Pediatric retinal photograph (wide-field); captured with the Clarity RetCam 3 (130° field of view): 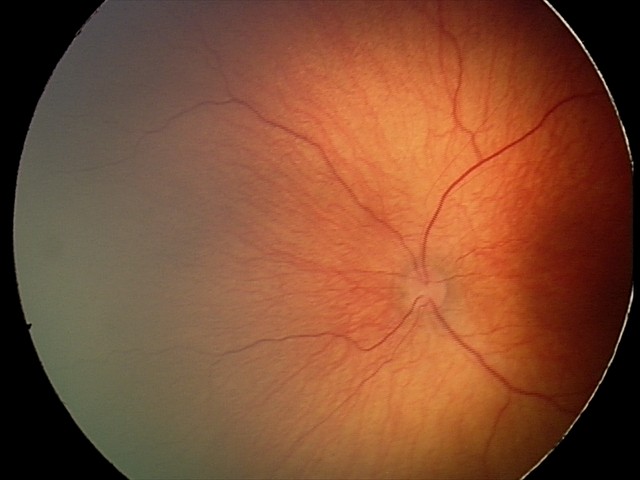

Screening examination consistent with status post retinopathy of prematurity (ROP).